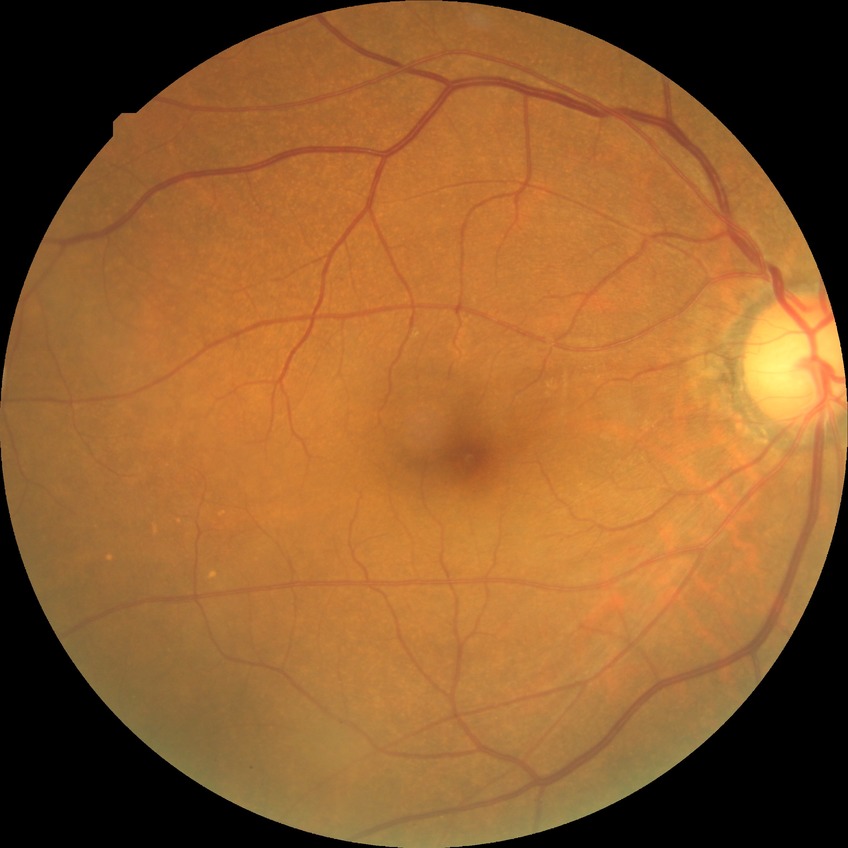
DR: NDR
DR impression: negative for DR